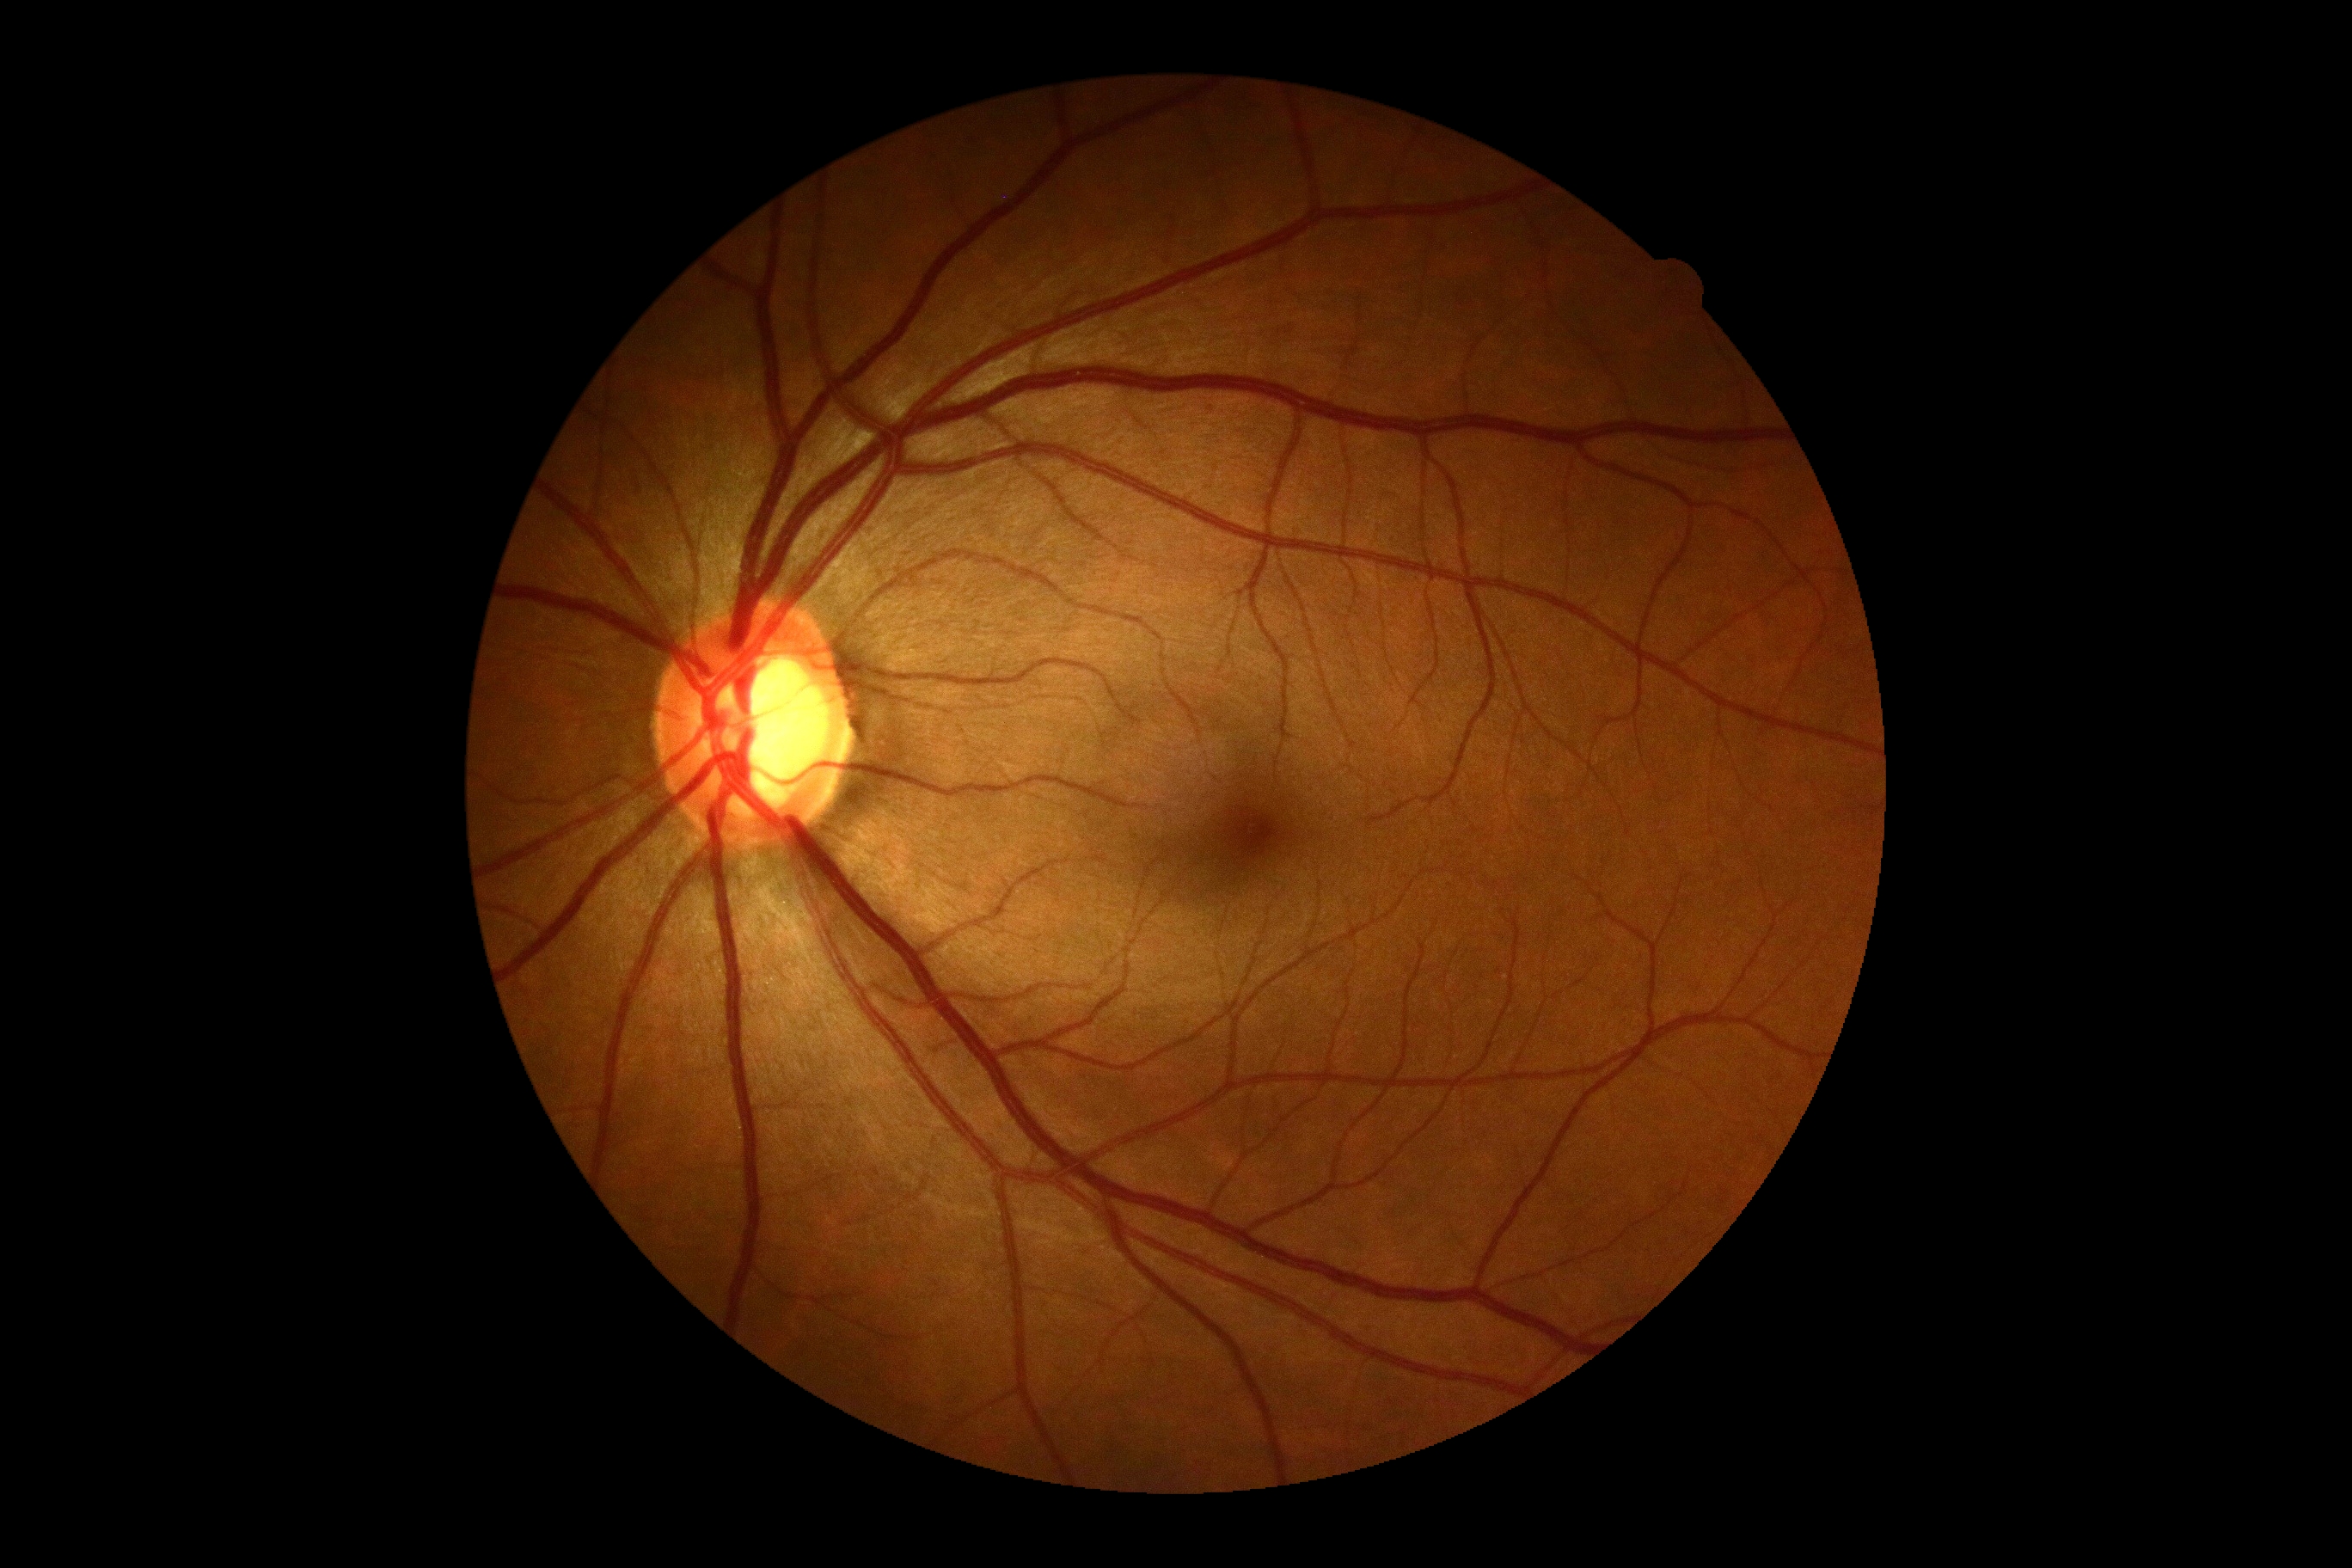
Retinopathy grade is 0 — no visible signs of diabetic retinopathy.